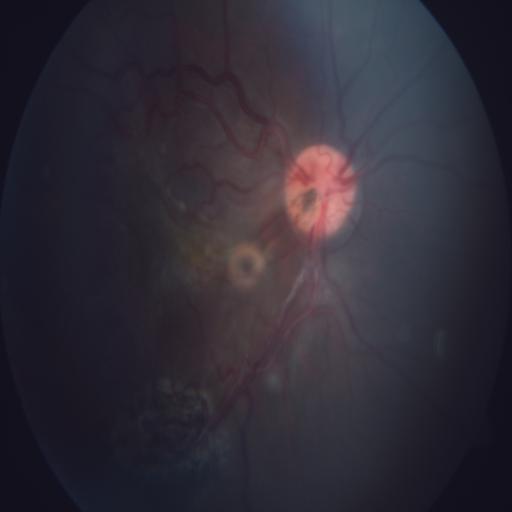

Two findings. Findings consistent with TV (tortuous vessels) and optic disc pit maculopathy.